Centered on the macula · 2361x1568px · retinal fundus photograph · Kowa VX-10α — 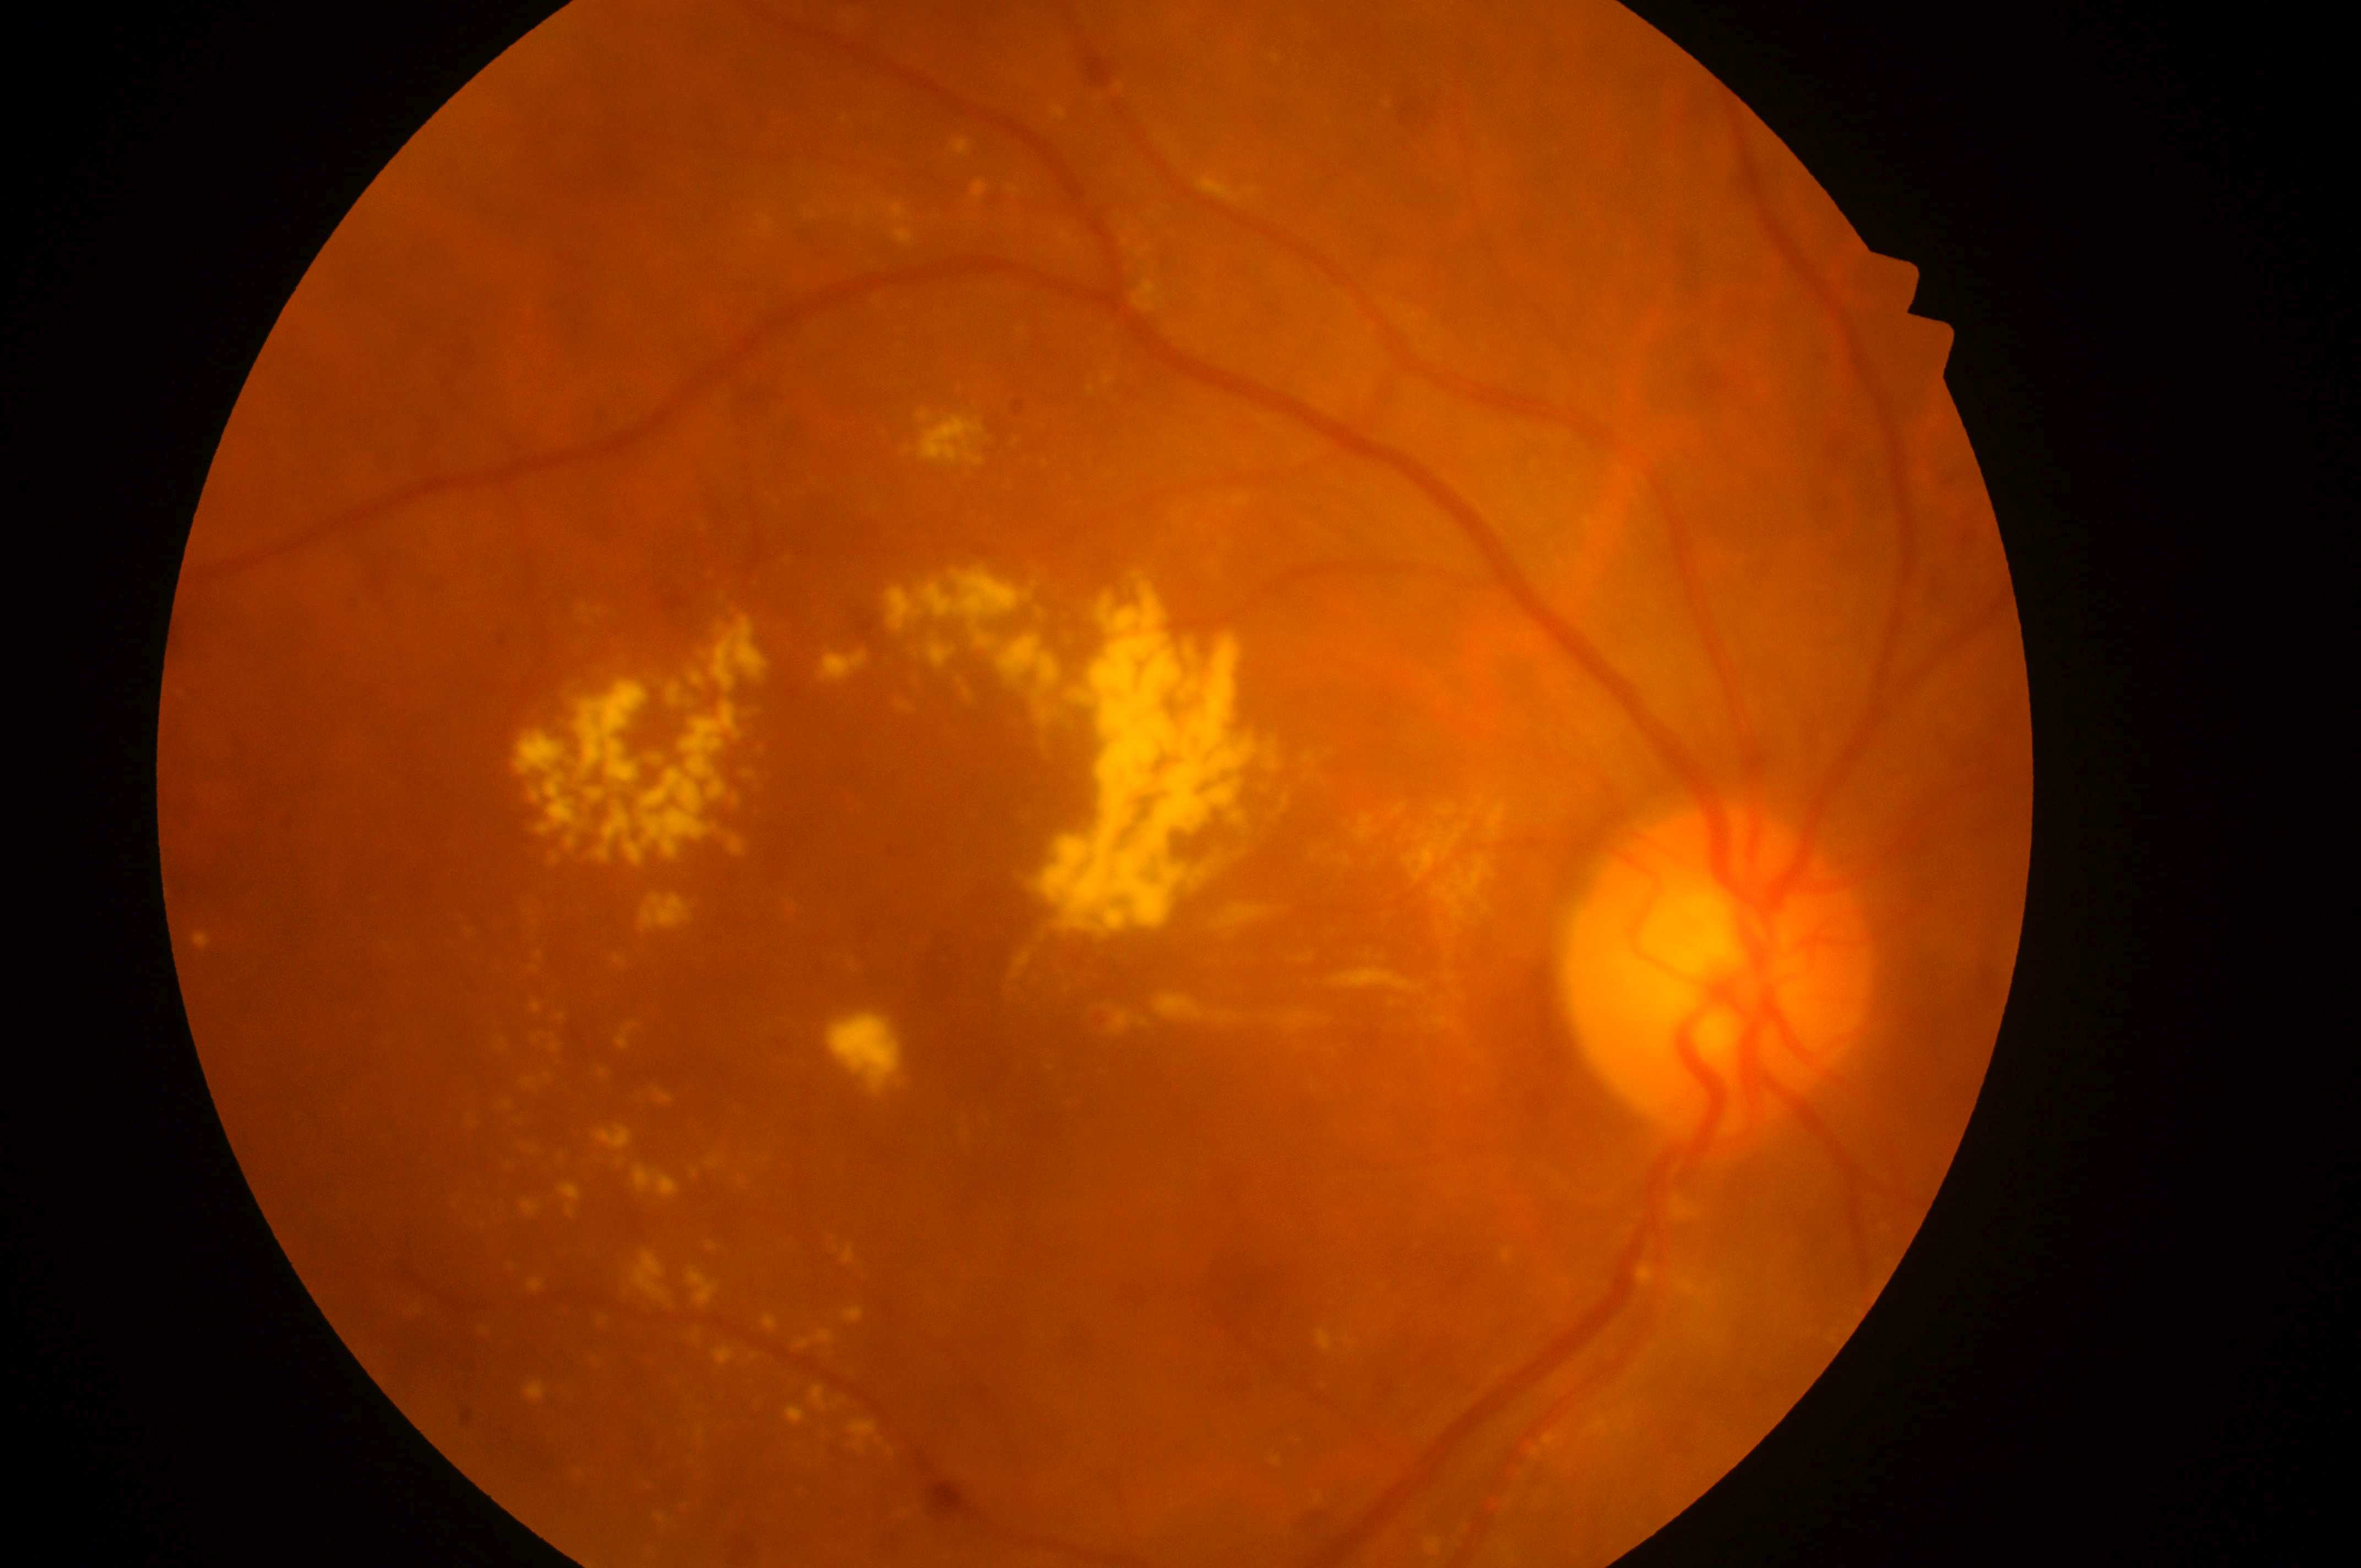

Q: What is the DR grade?
A: grade 2
Q: Optic disc center?
A: (1706, 981)
Q: What is the laterality?
A: right eye
Q: What is the DME risk grade?
A: 2
Q: Where is the fovea?
A: (1000, 1027)